Wide-field fundus photograph from neonatal ROP screening; 640x480
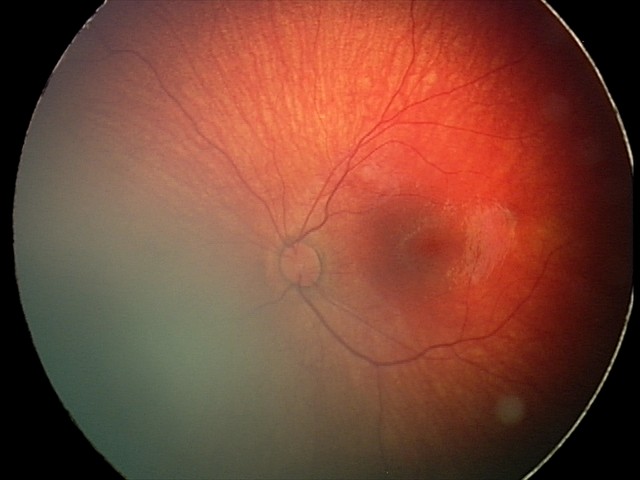
Assessment: retinal hemorrhages.